Color fundus image · NIDEK AFC-230 fundus camera: 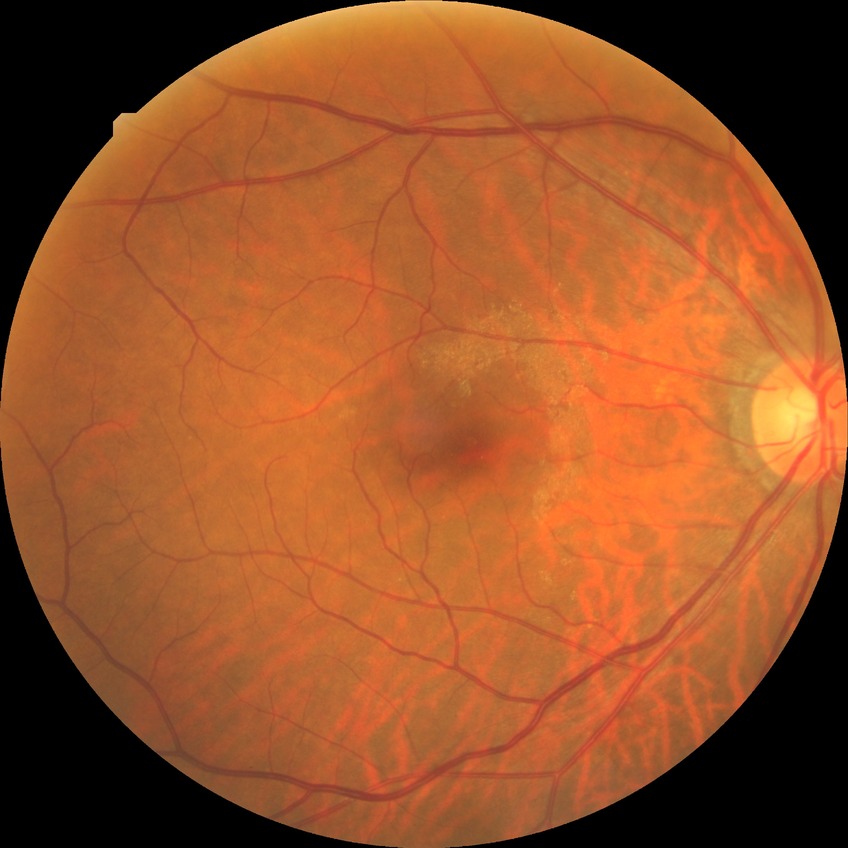
diabetic retinopathy (DR): no diabetic retinopathy (NDR)